Color fundus photograph
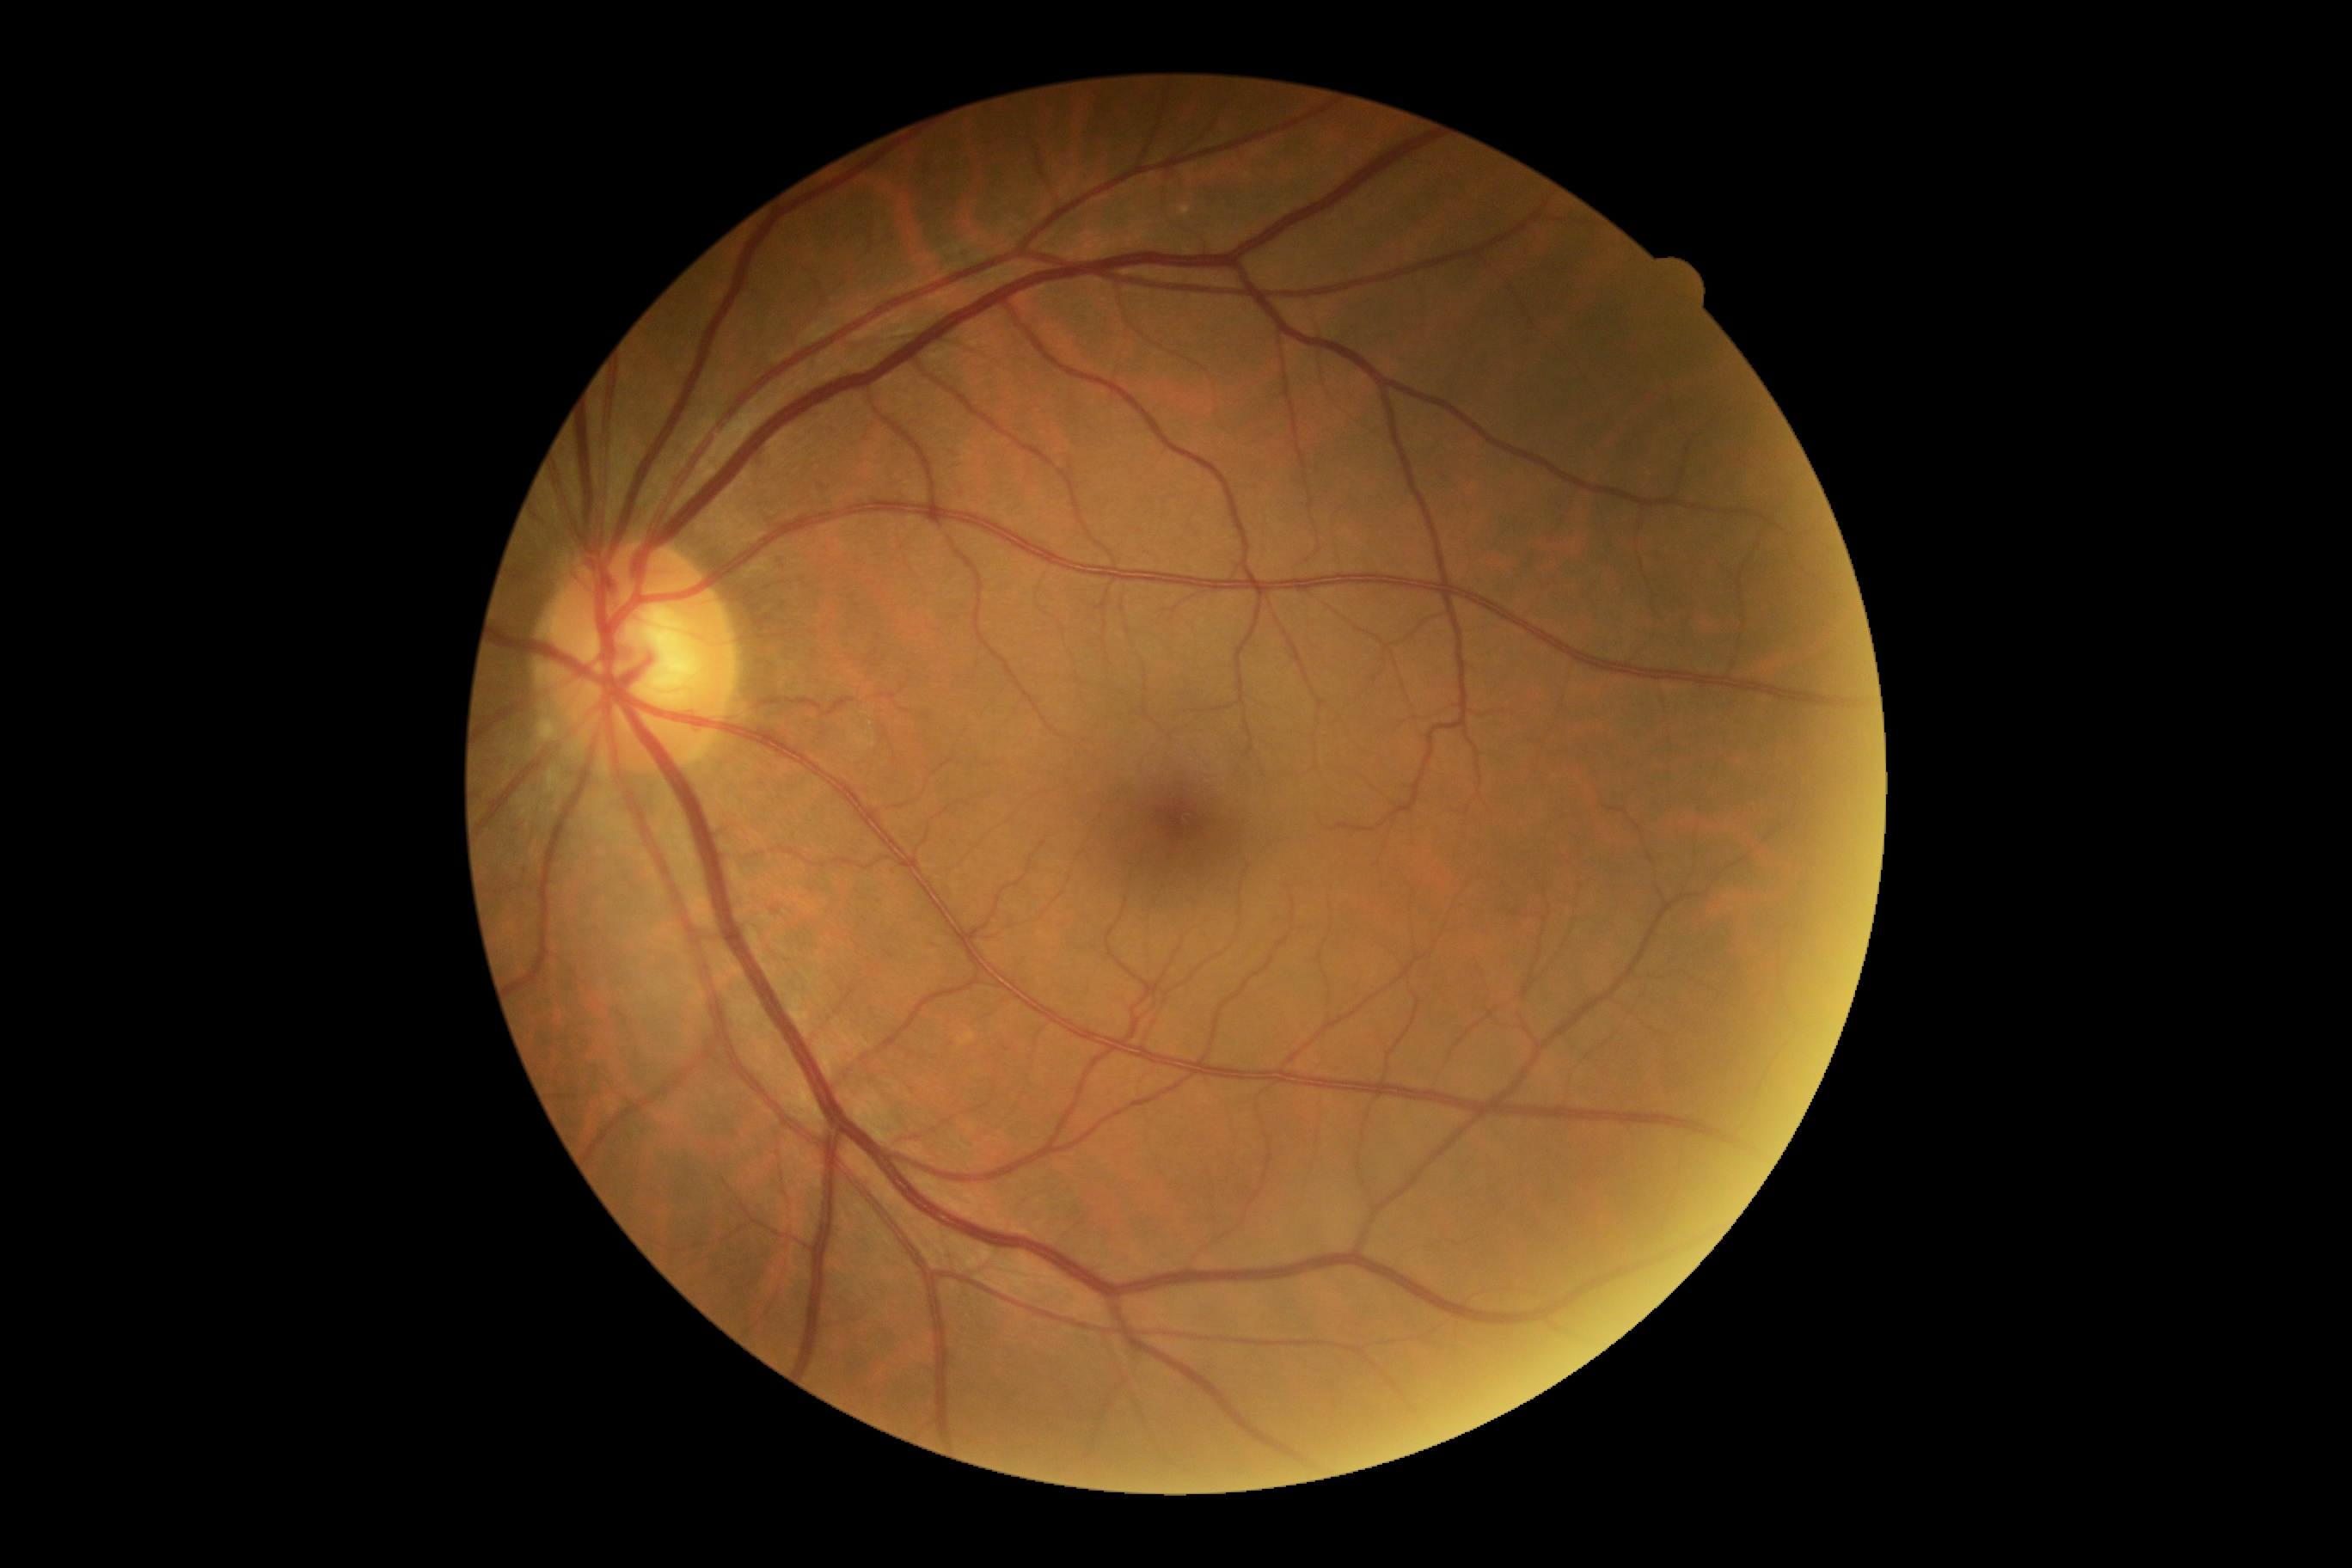
* DR impression: no DR findings
* retinopathy: grade 0